Pediatric wide-field fundus photograph · image size 1440x1080: 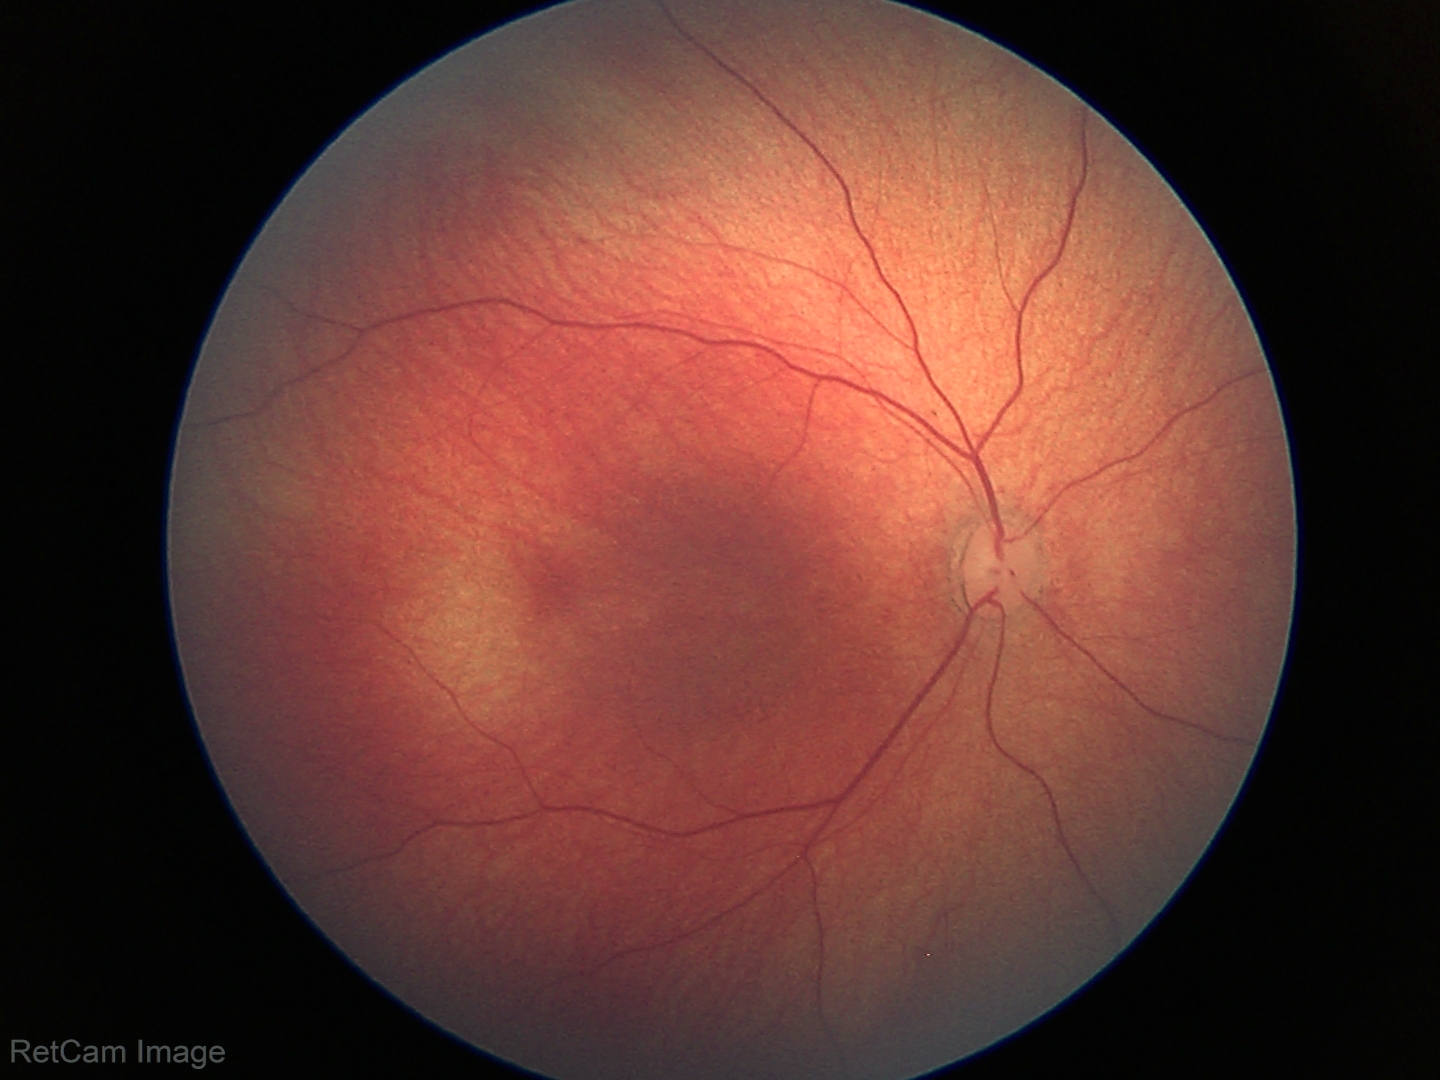
No retinal pathology identified on screening.